1240x1240px · pediatric wide-field fundus photograph · 100° field of view (Phoenix ICON)
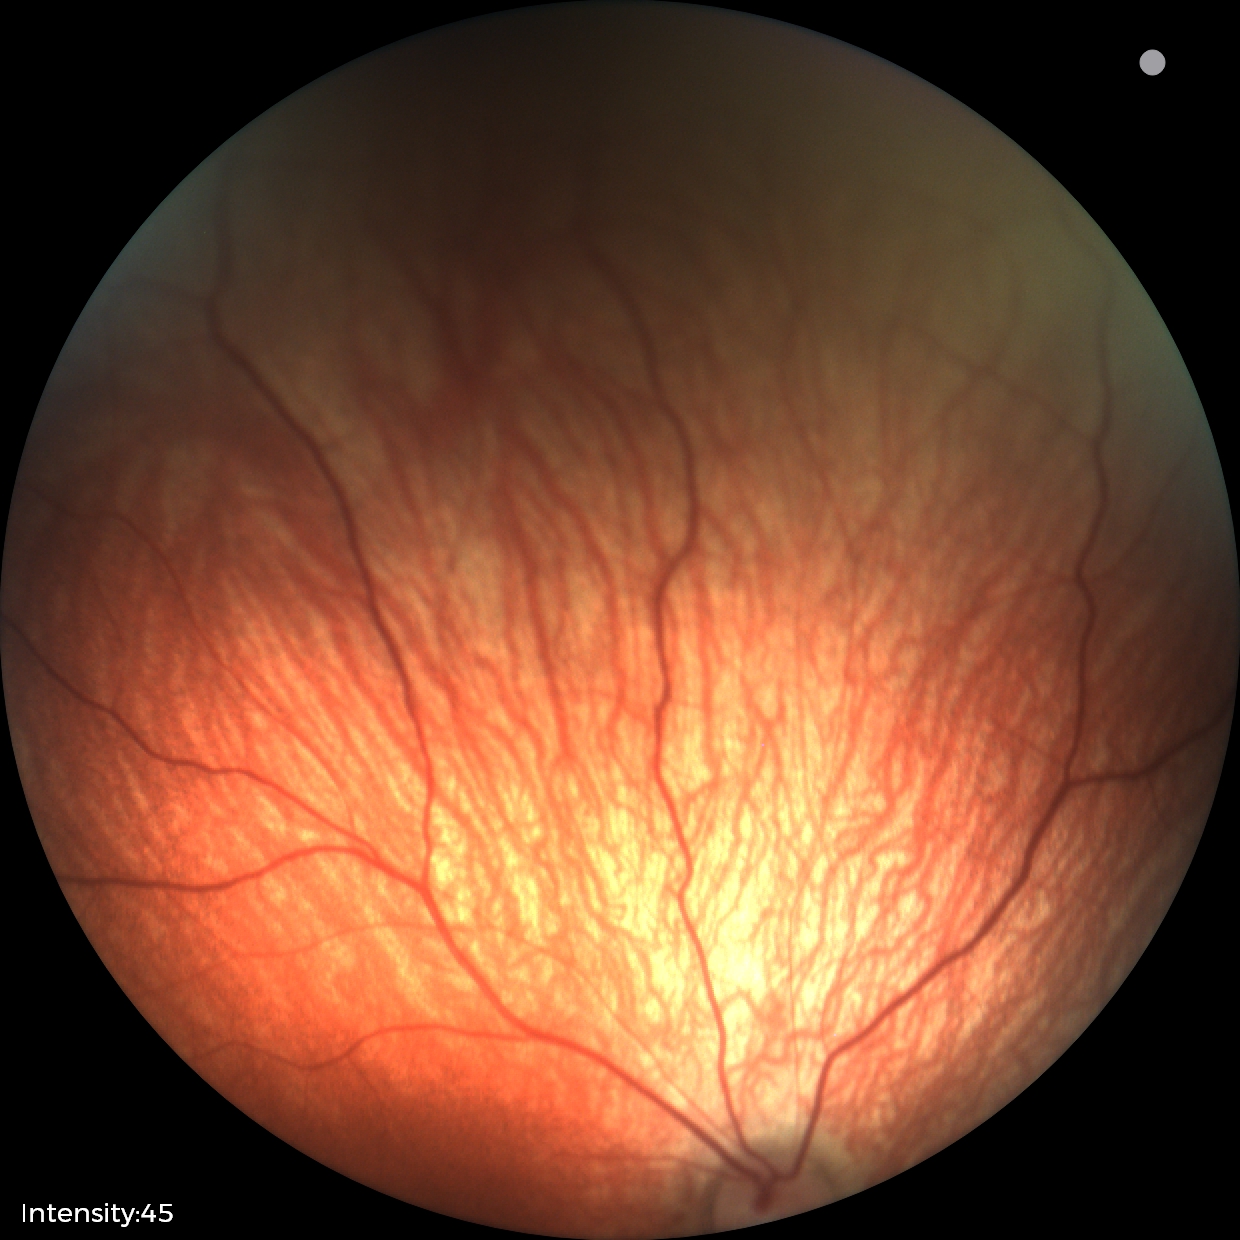 Physiological retinal appearance for postconceptual age.